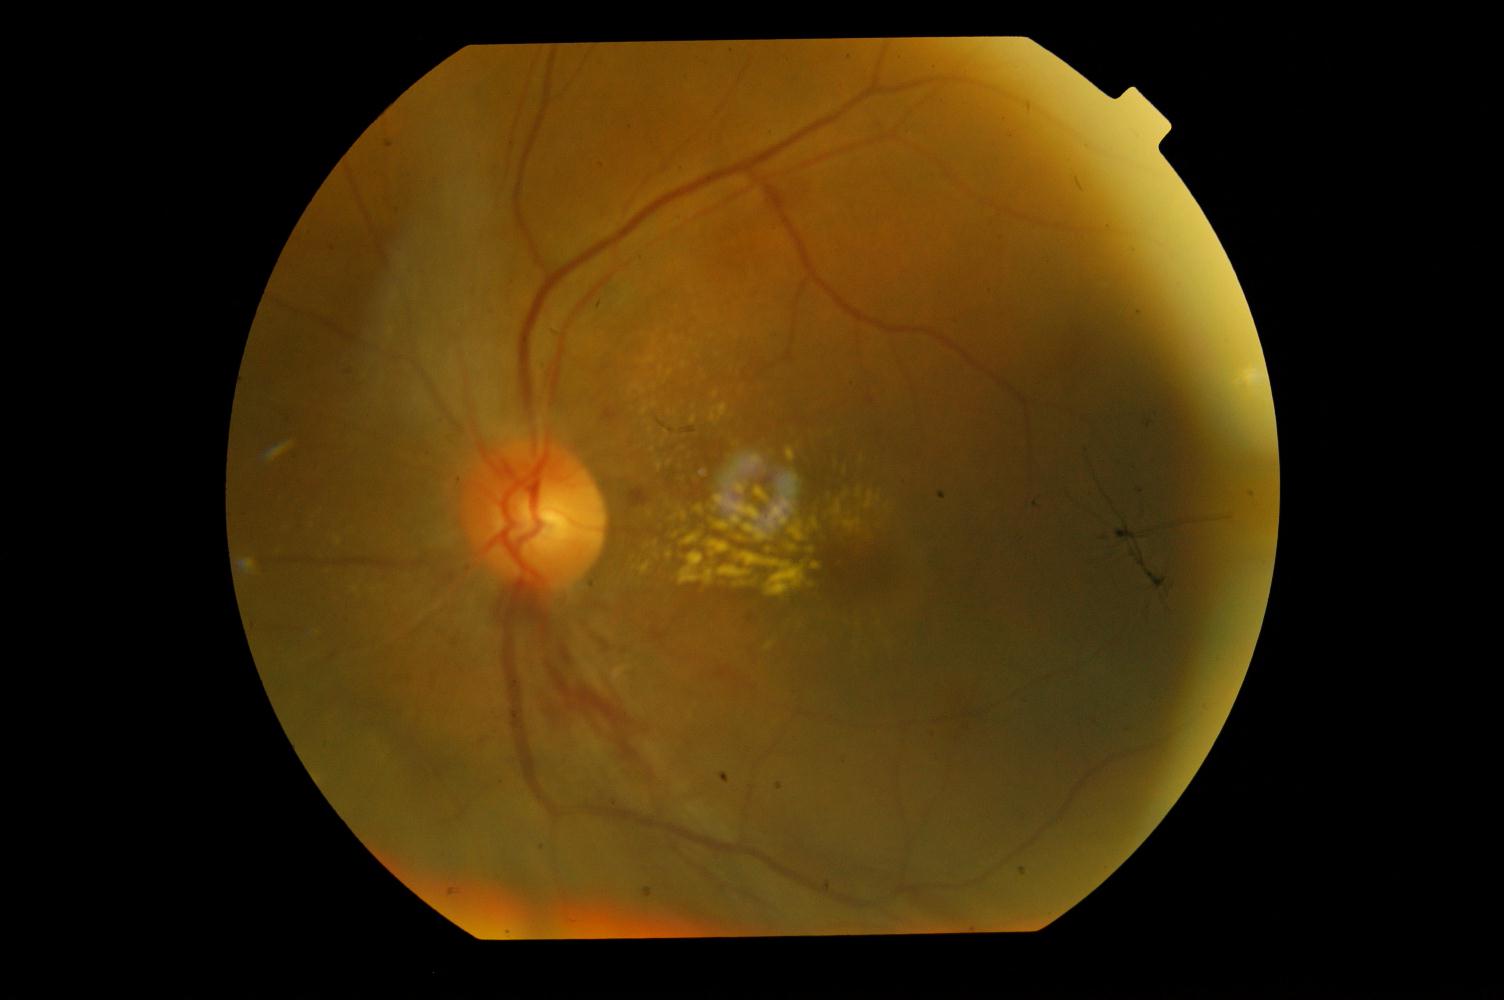

Fundus appearance consistent with HTN (hypertensive retinopathy).